Centered on the optic disc
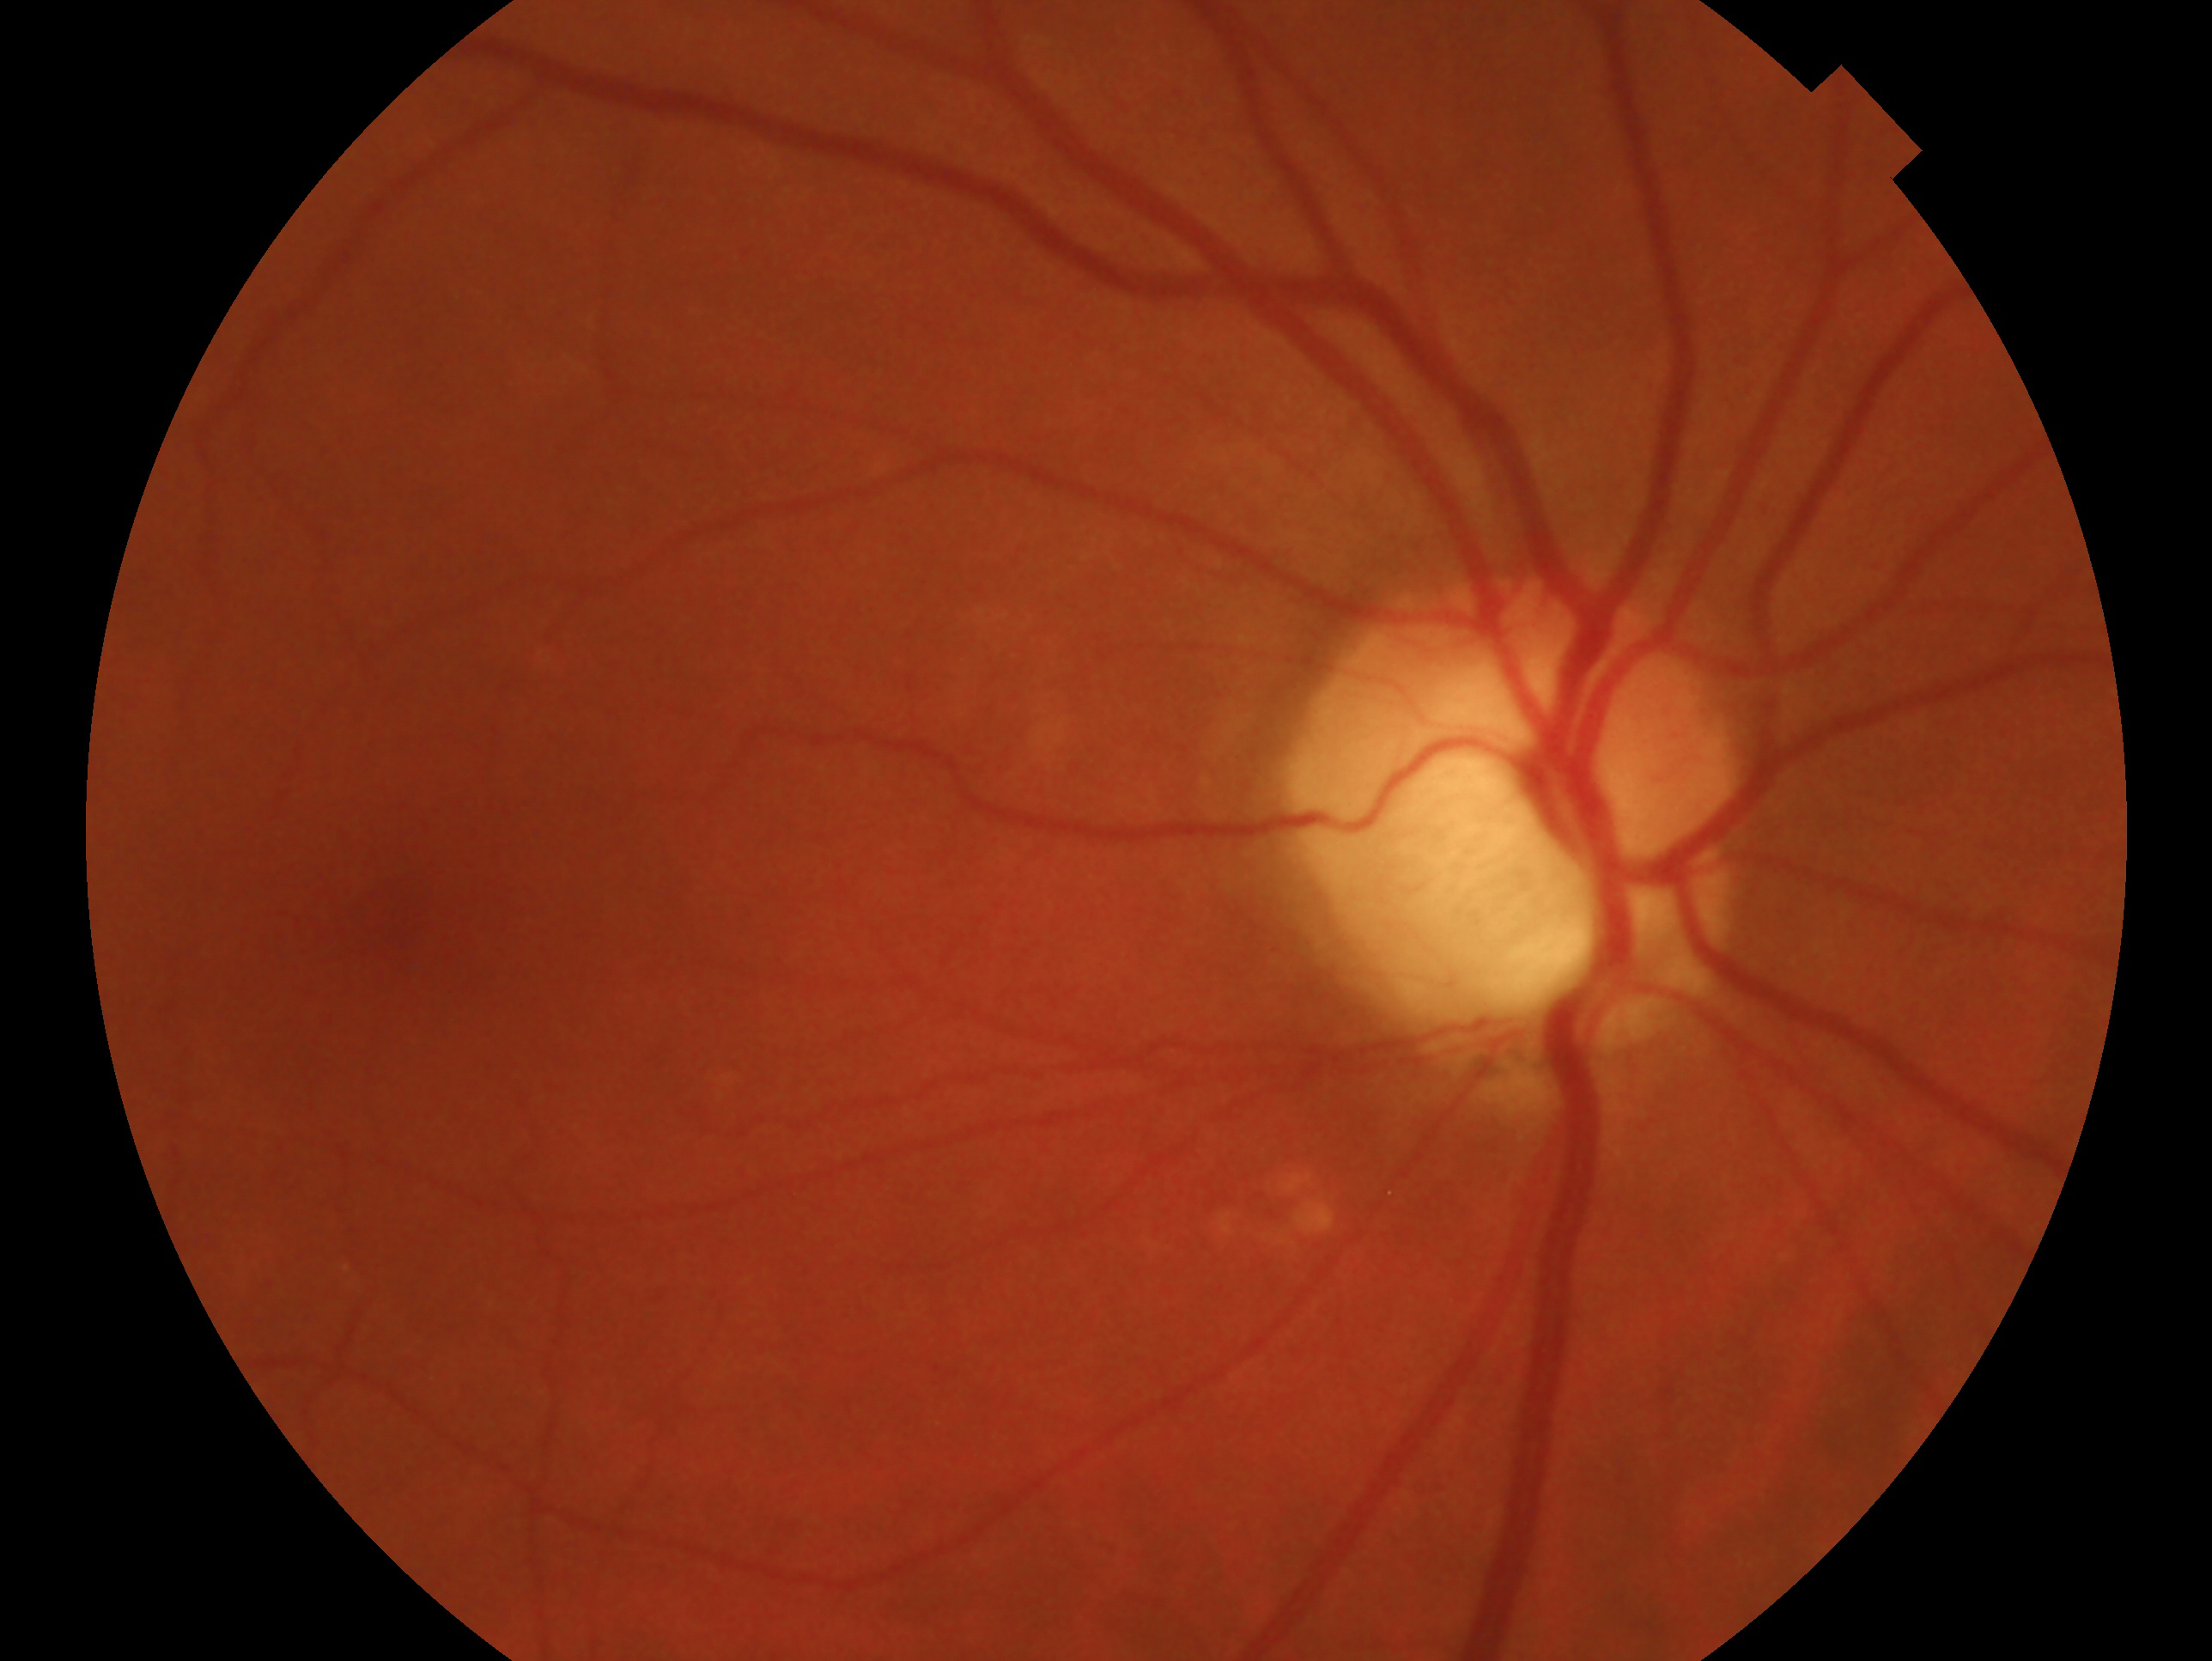
impression: glaucomatous
laterality: right